Acquired with a NIDEK AFC-230 · 848x848 · fundus photo — 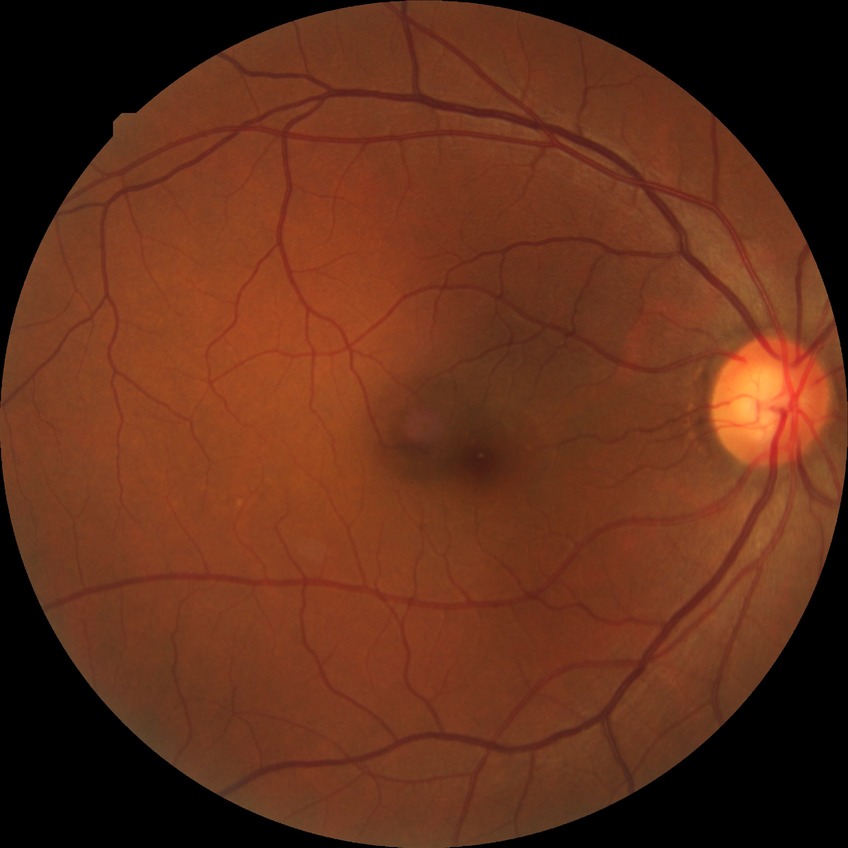

Assessment:
– Davis grade — NDR